Acquired on the Phoenix ICON. Pediatric retinal photograph (wide-field):
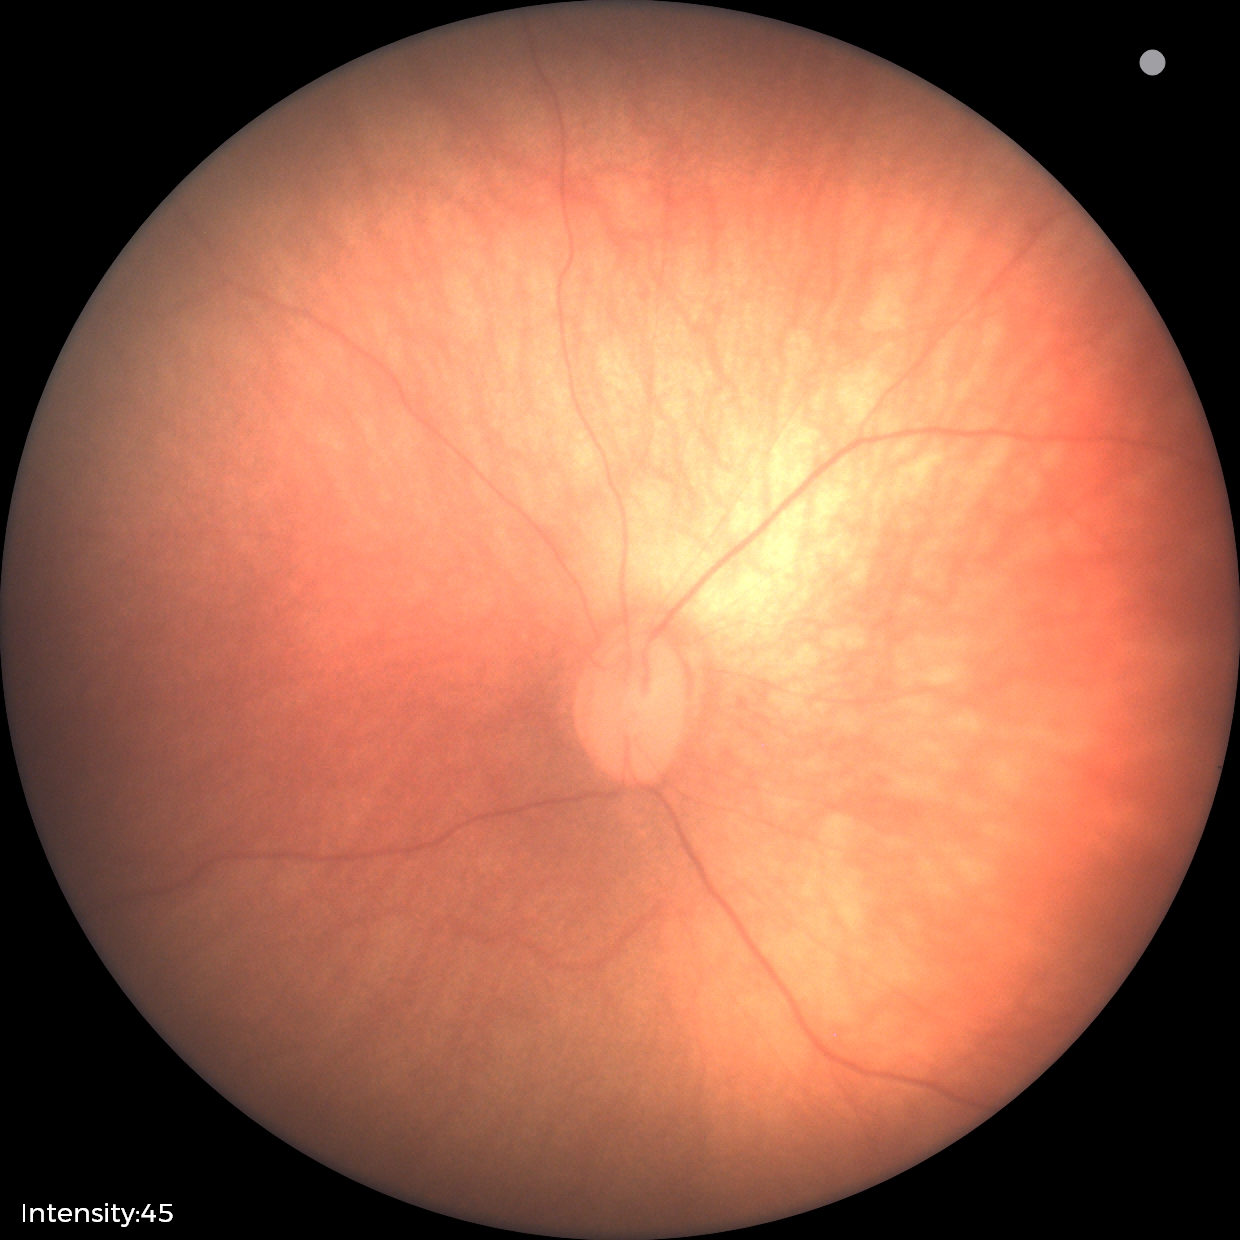 Screening examination with no abnormal retinal findings.